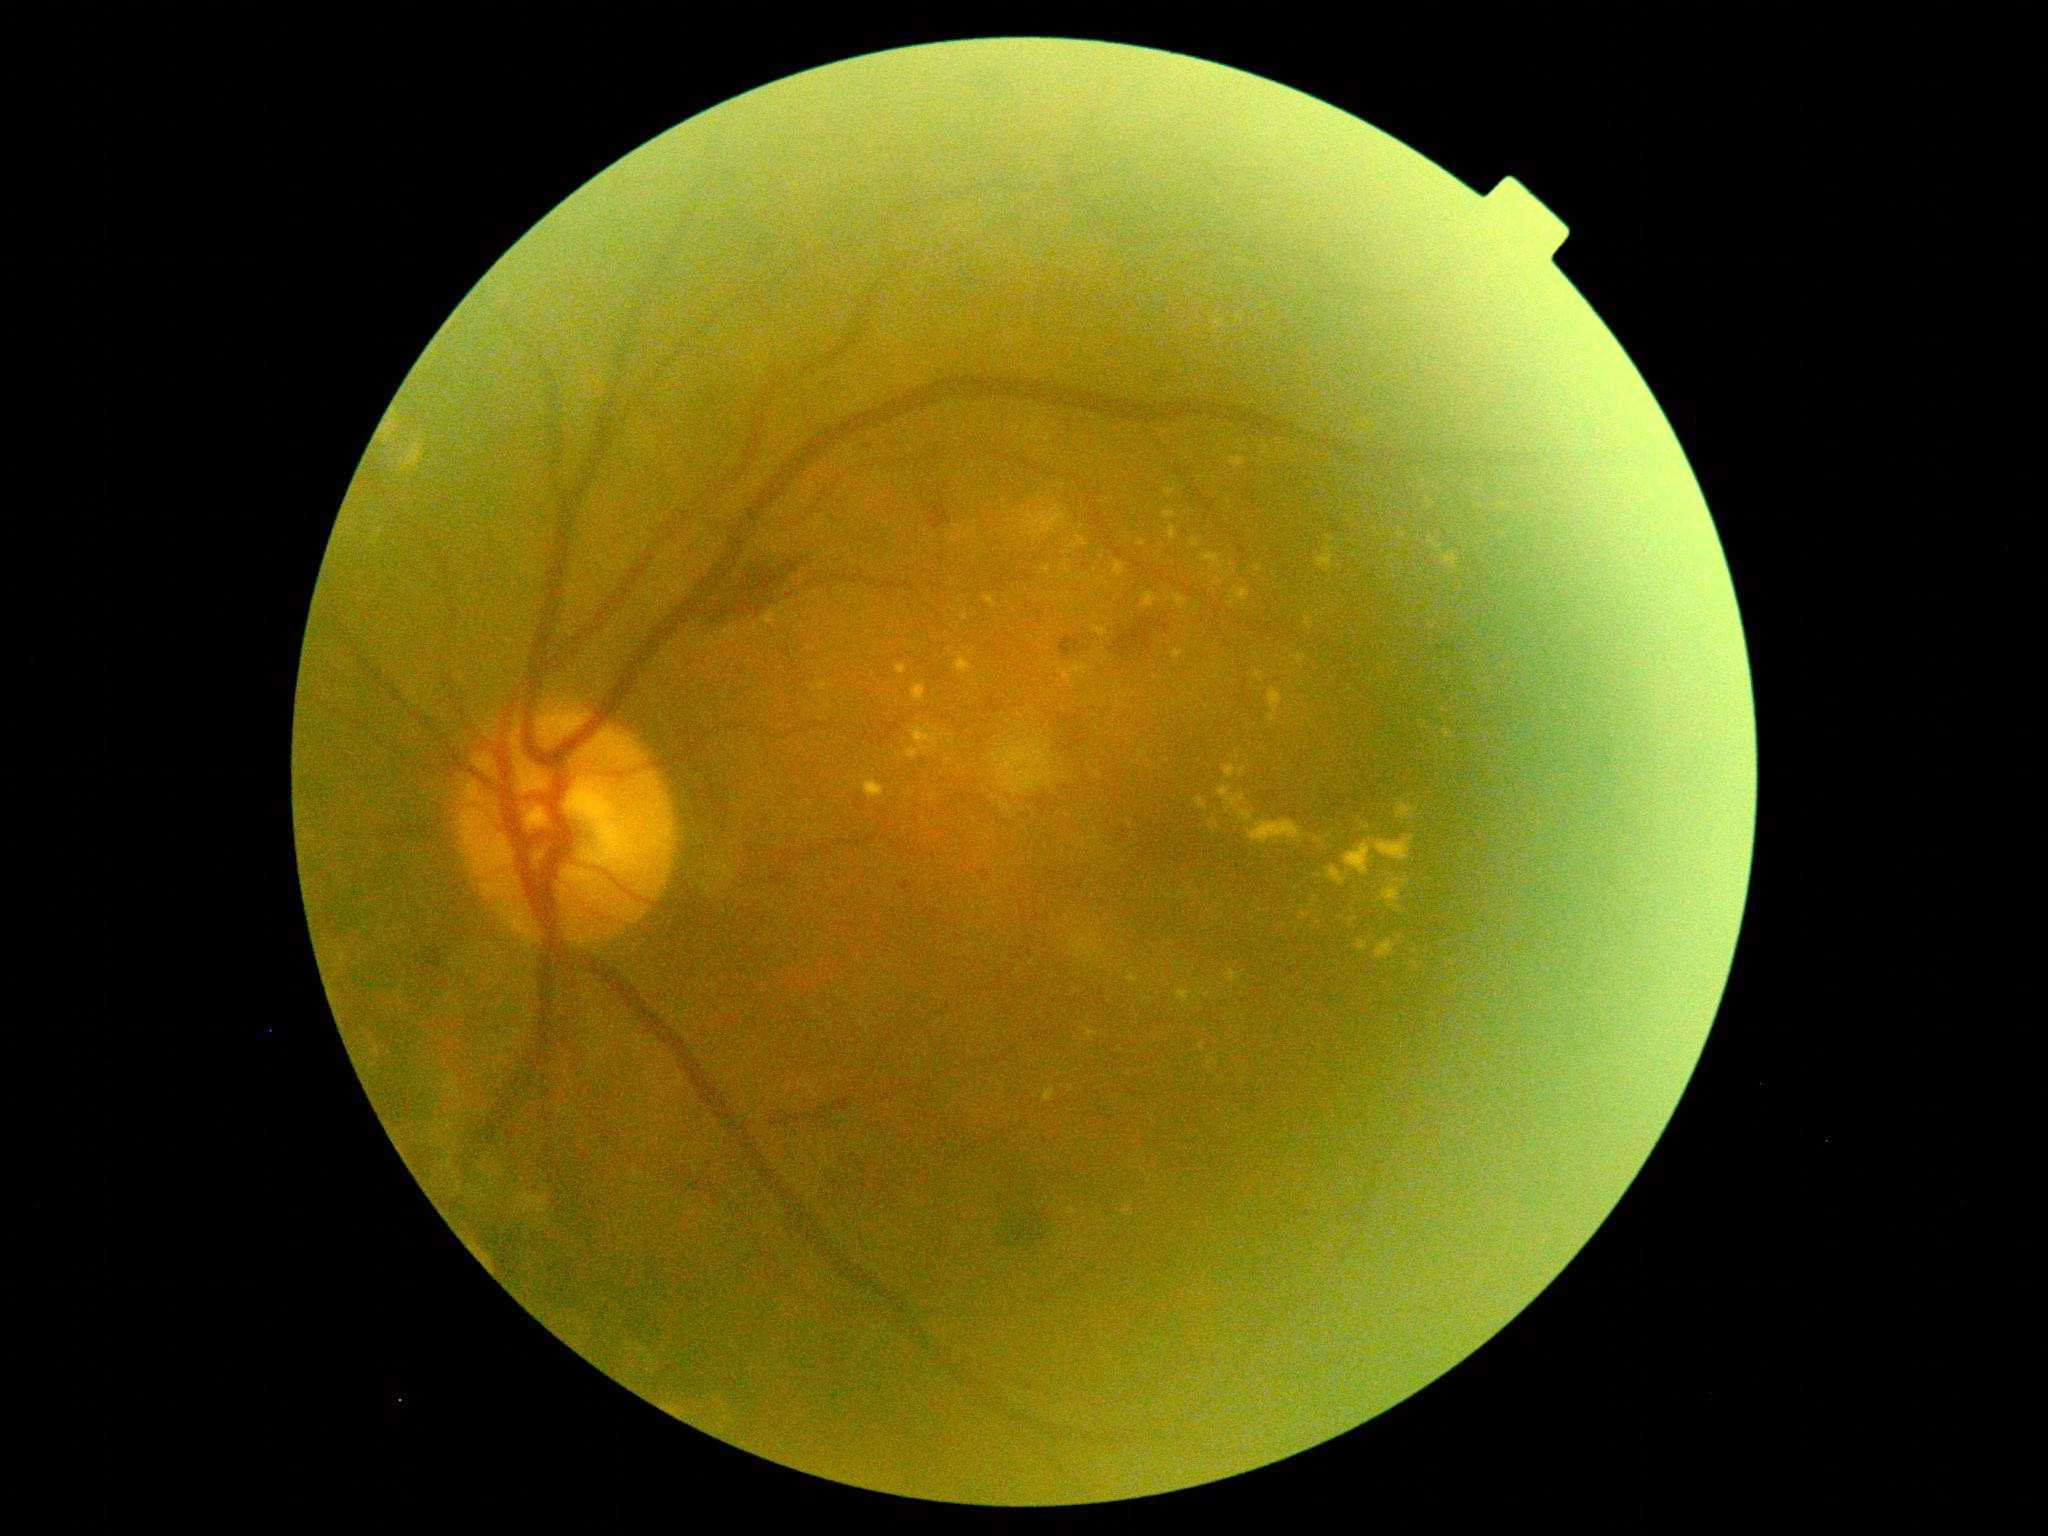

diabetic retinopathy grade: 2.